45° FOV, CFP:
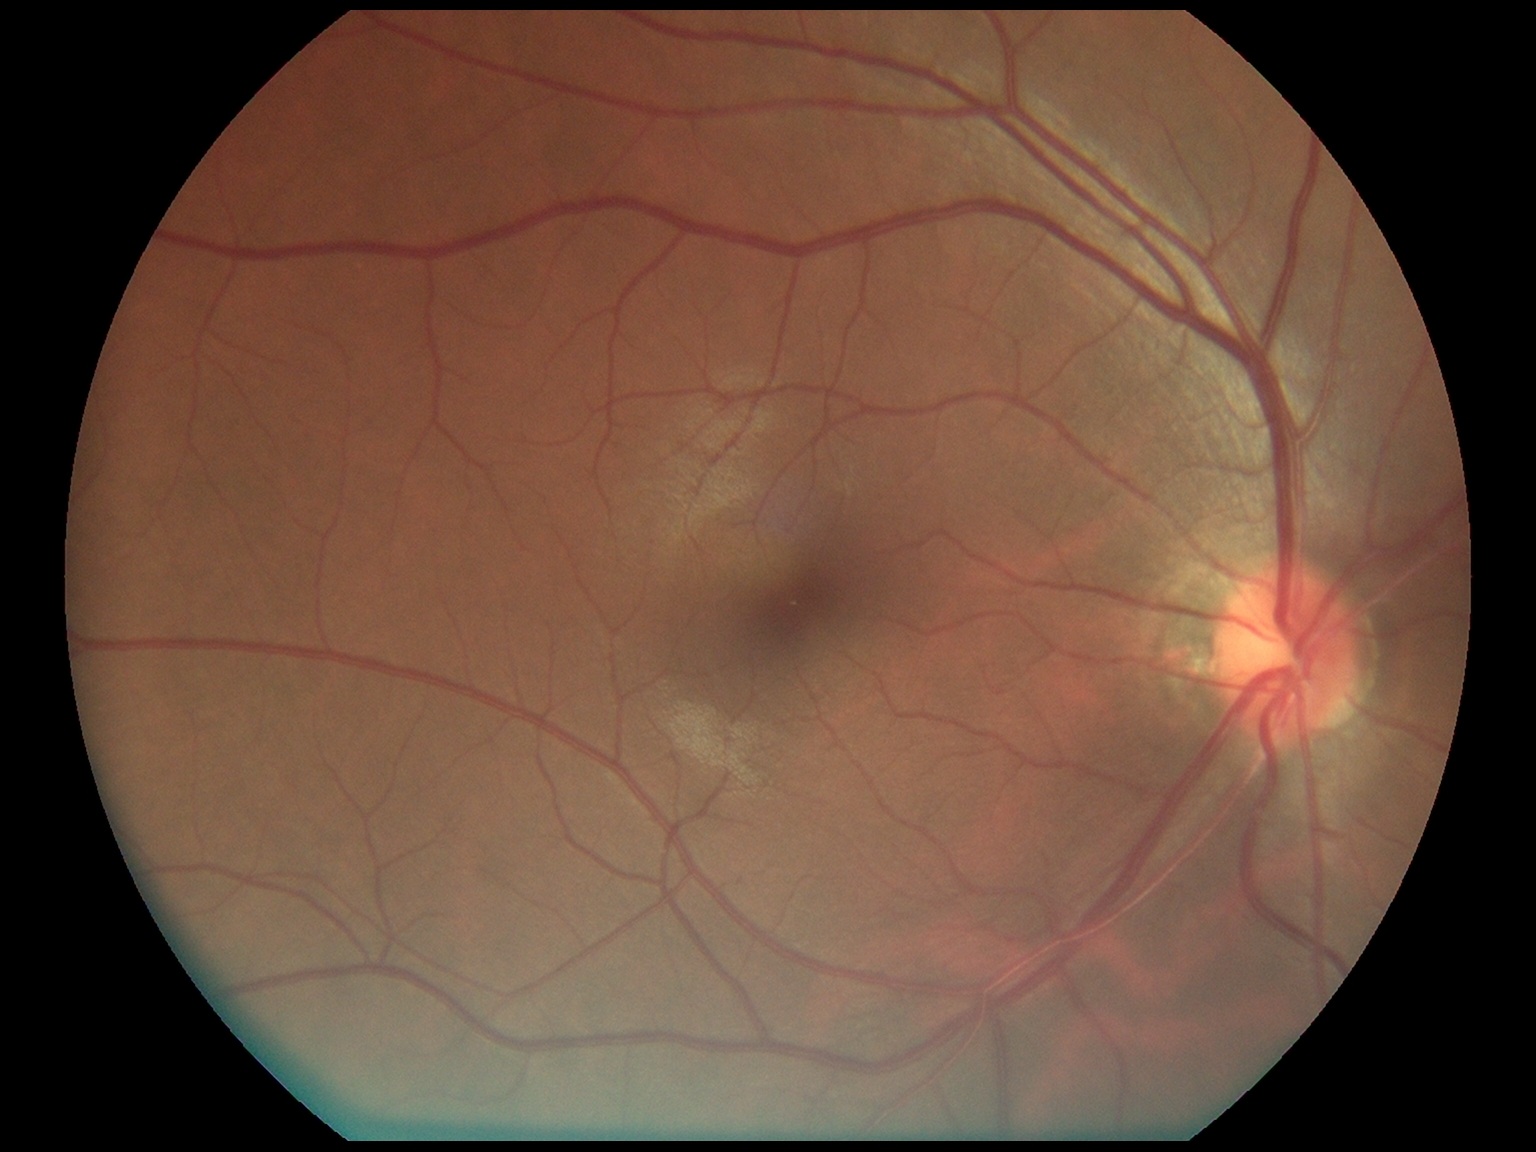

DR grade: no apparent retinopathy (0).